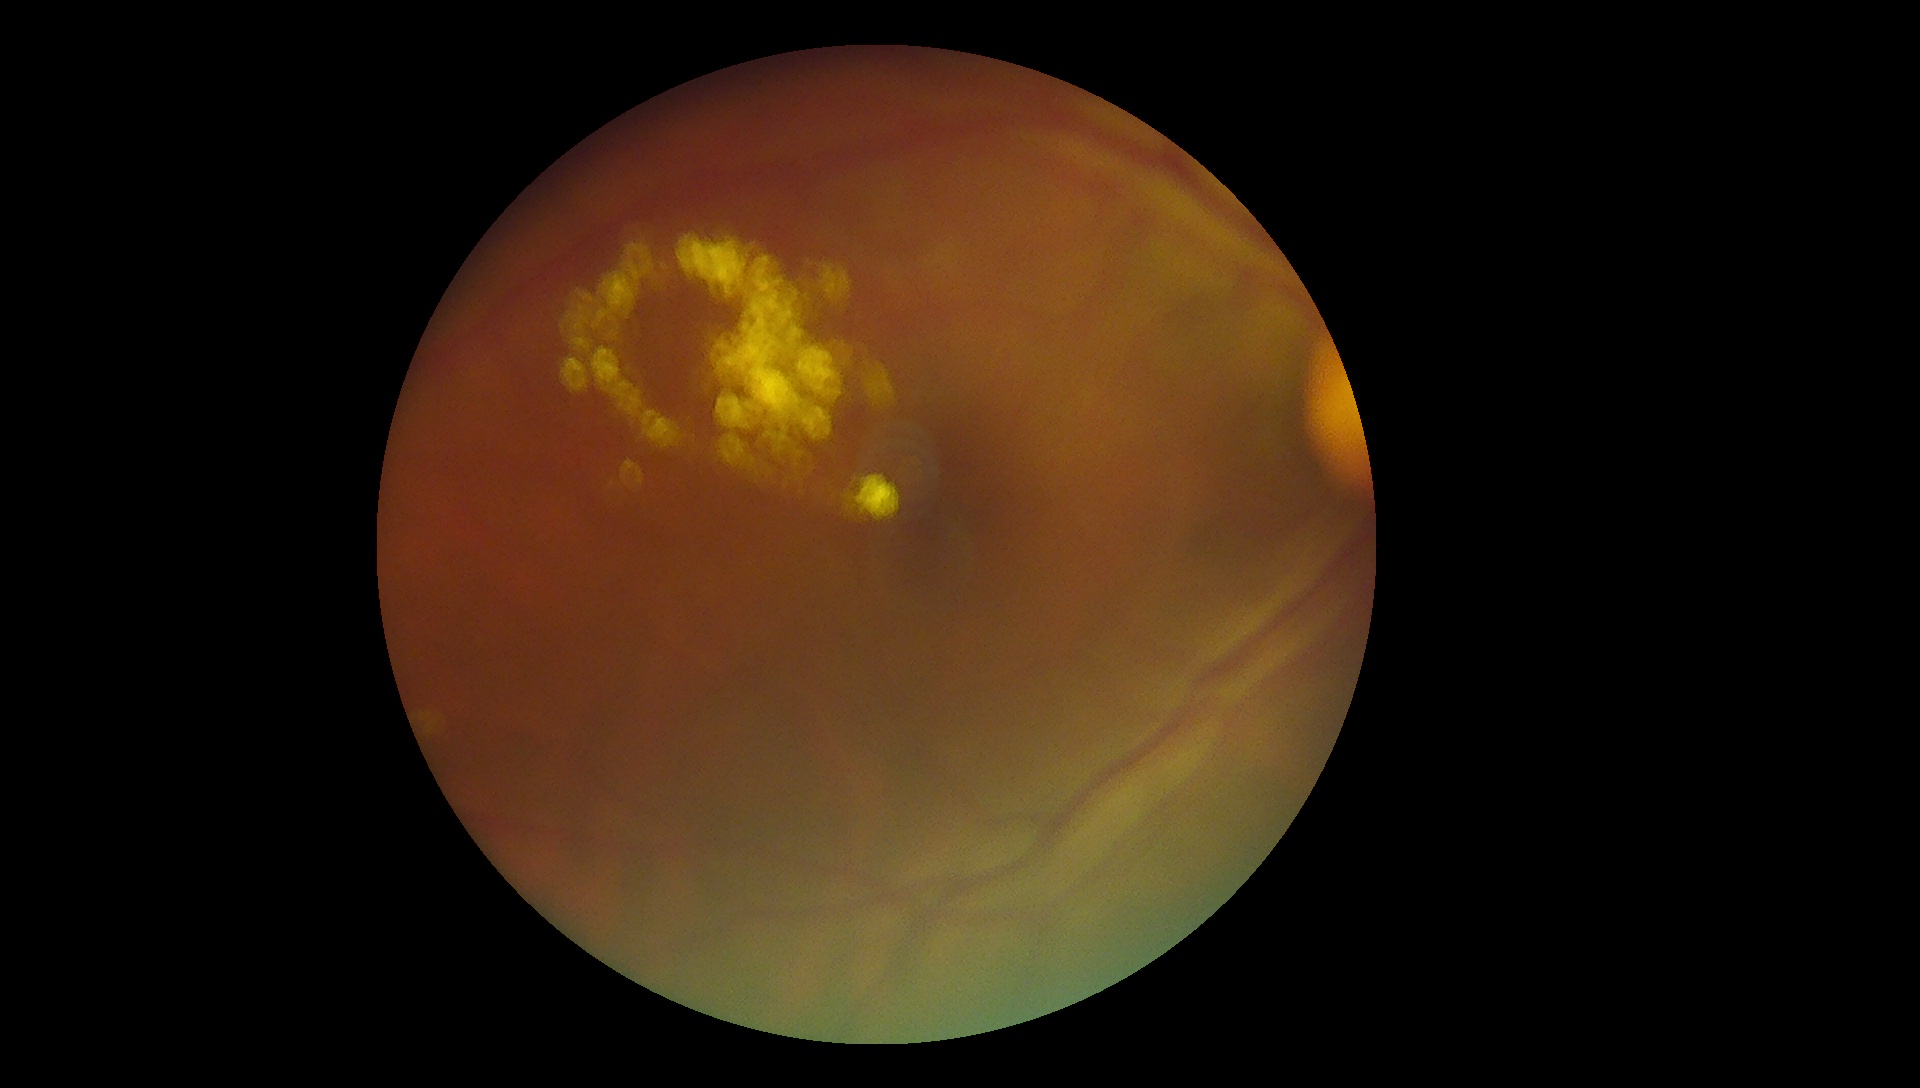 Retinopathy is 2.